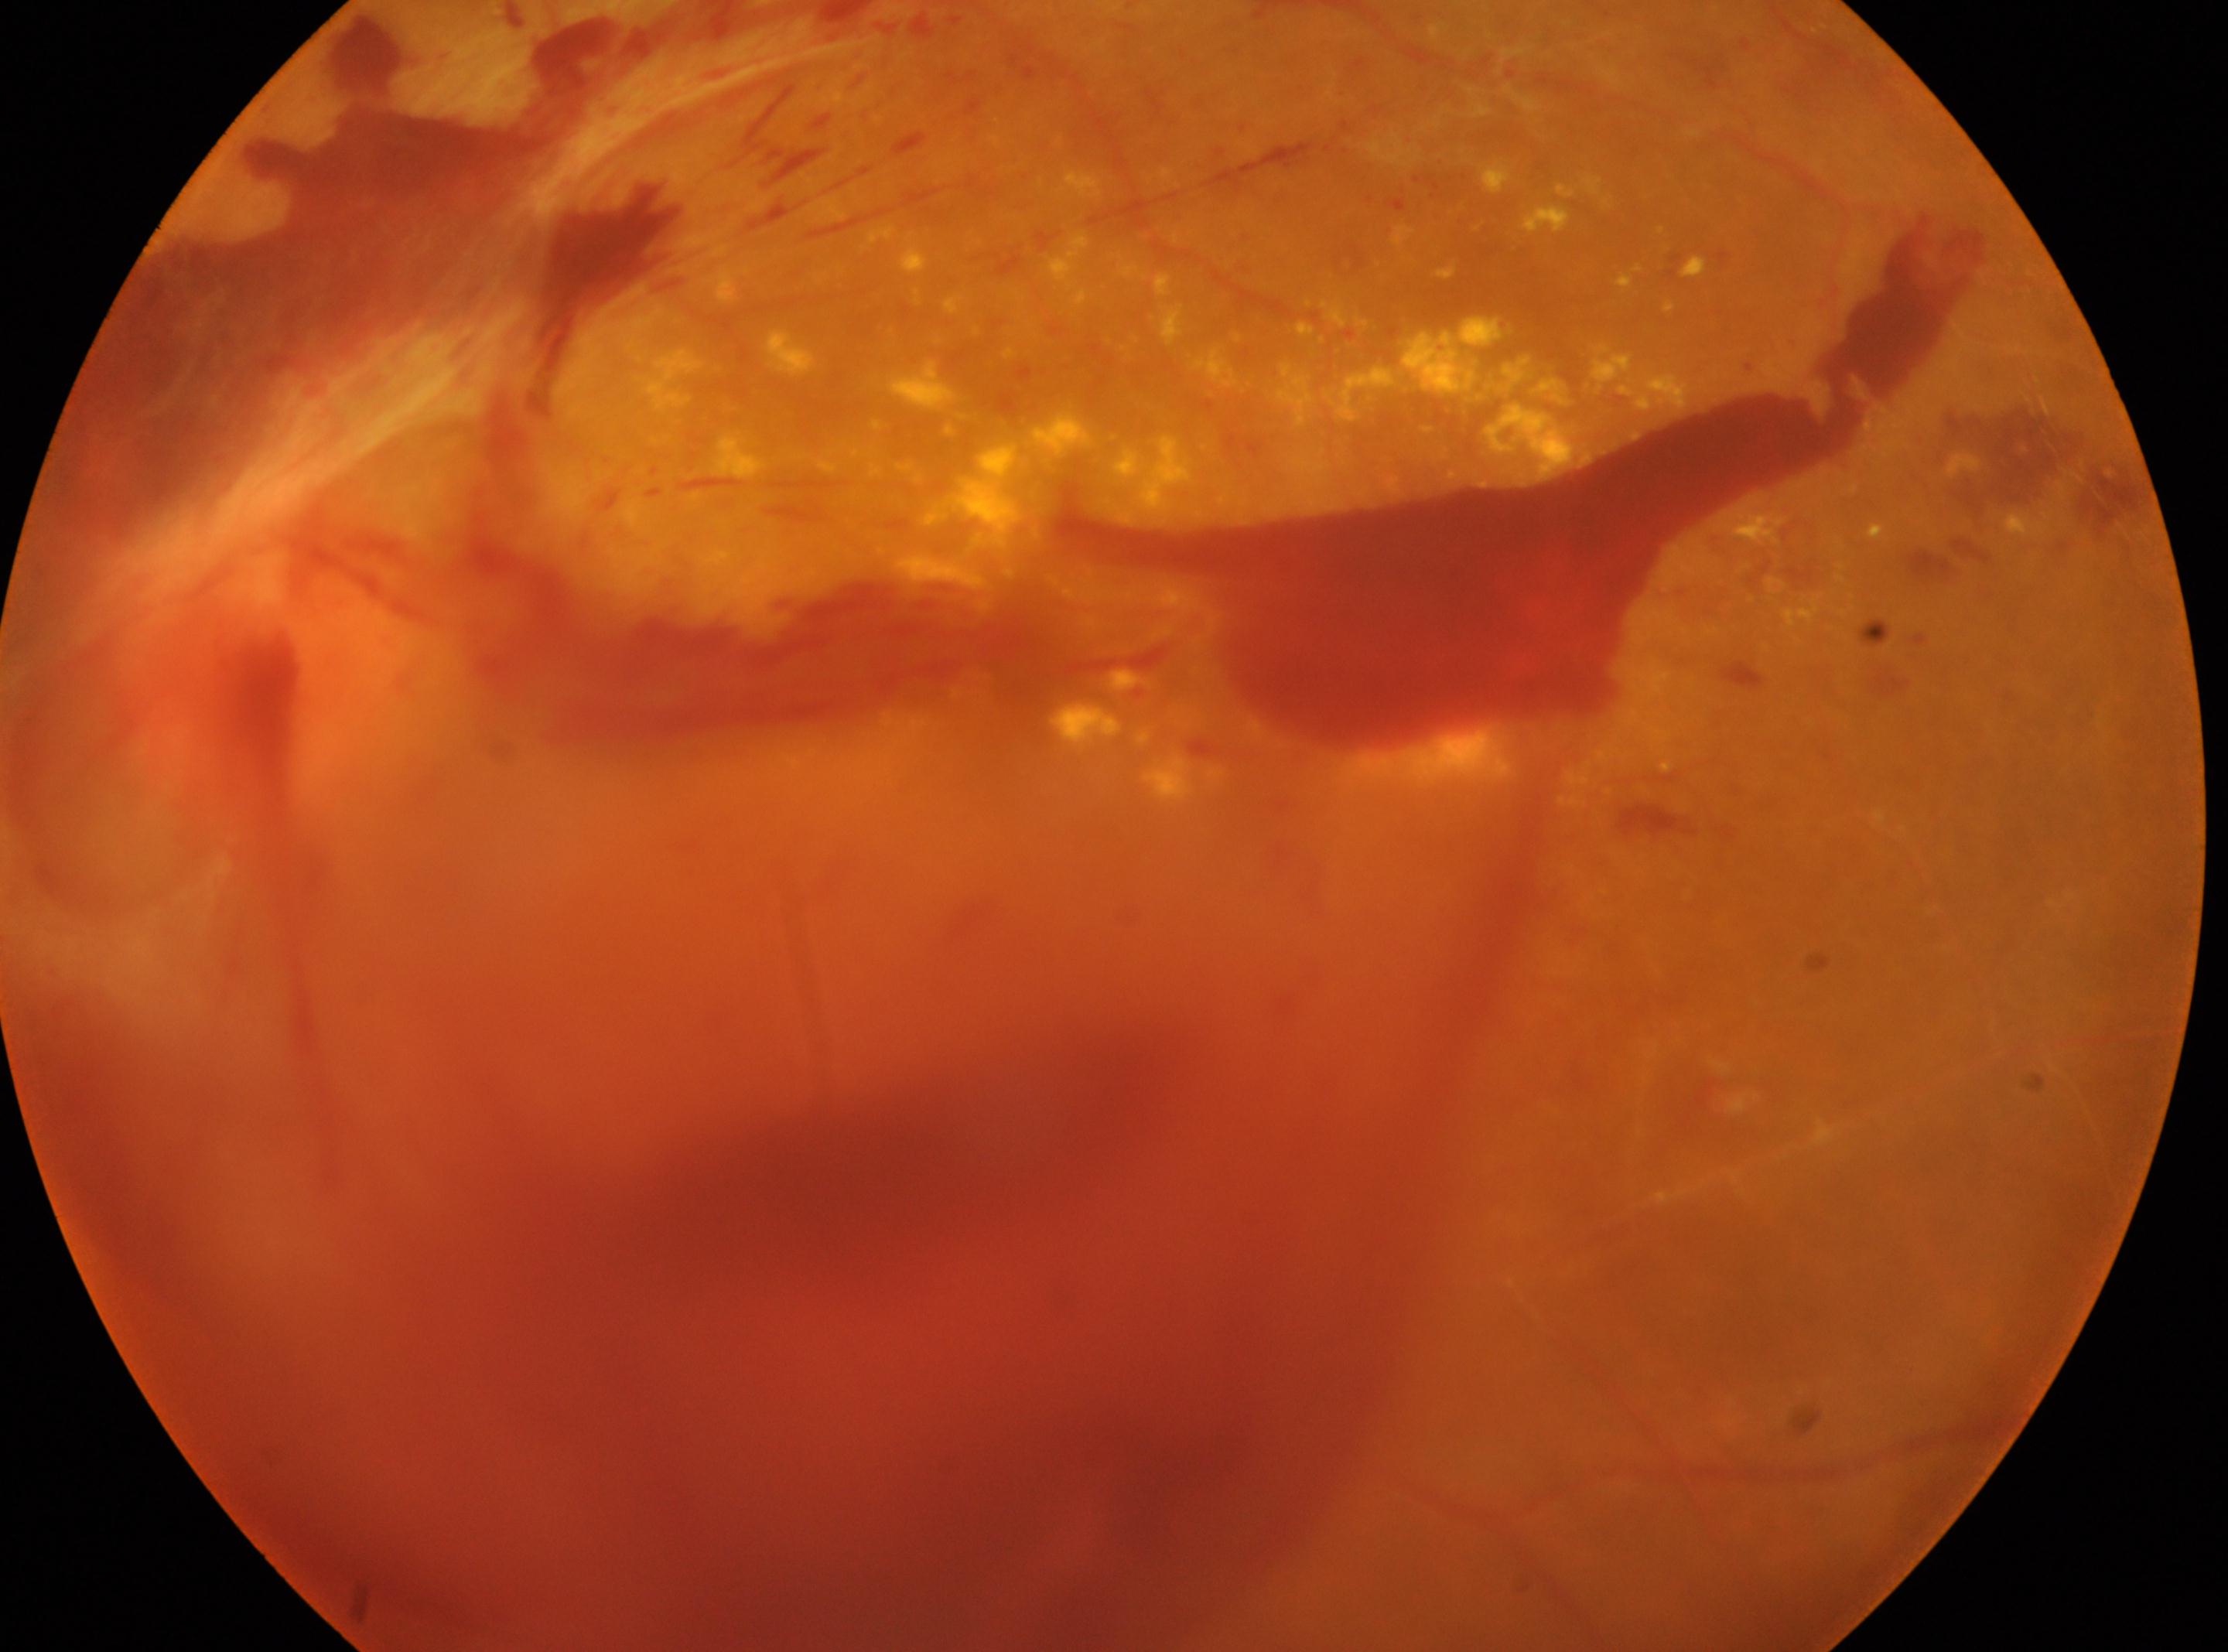

oculus sinister
proliferative diabetic retinopathy
macular center: (x: 1066, y: 857)
optic disc center: (x: 271, y: 619)
DR grade: 4 — neovascularization and/or vitreous/pre-retinal hemorrhage